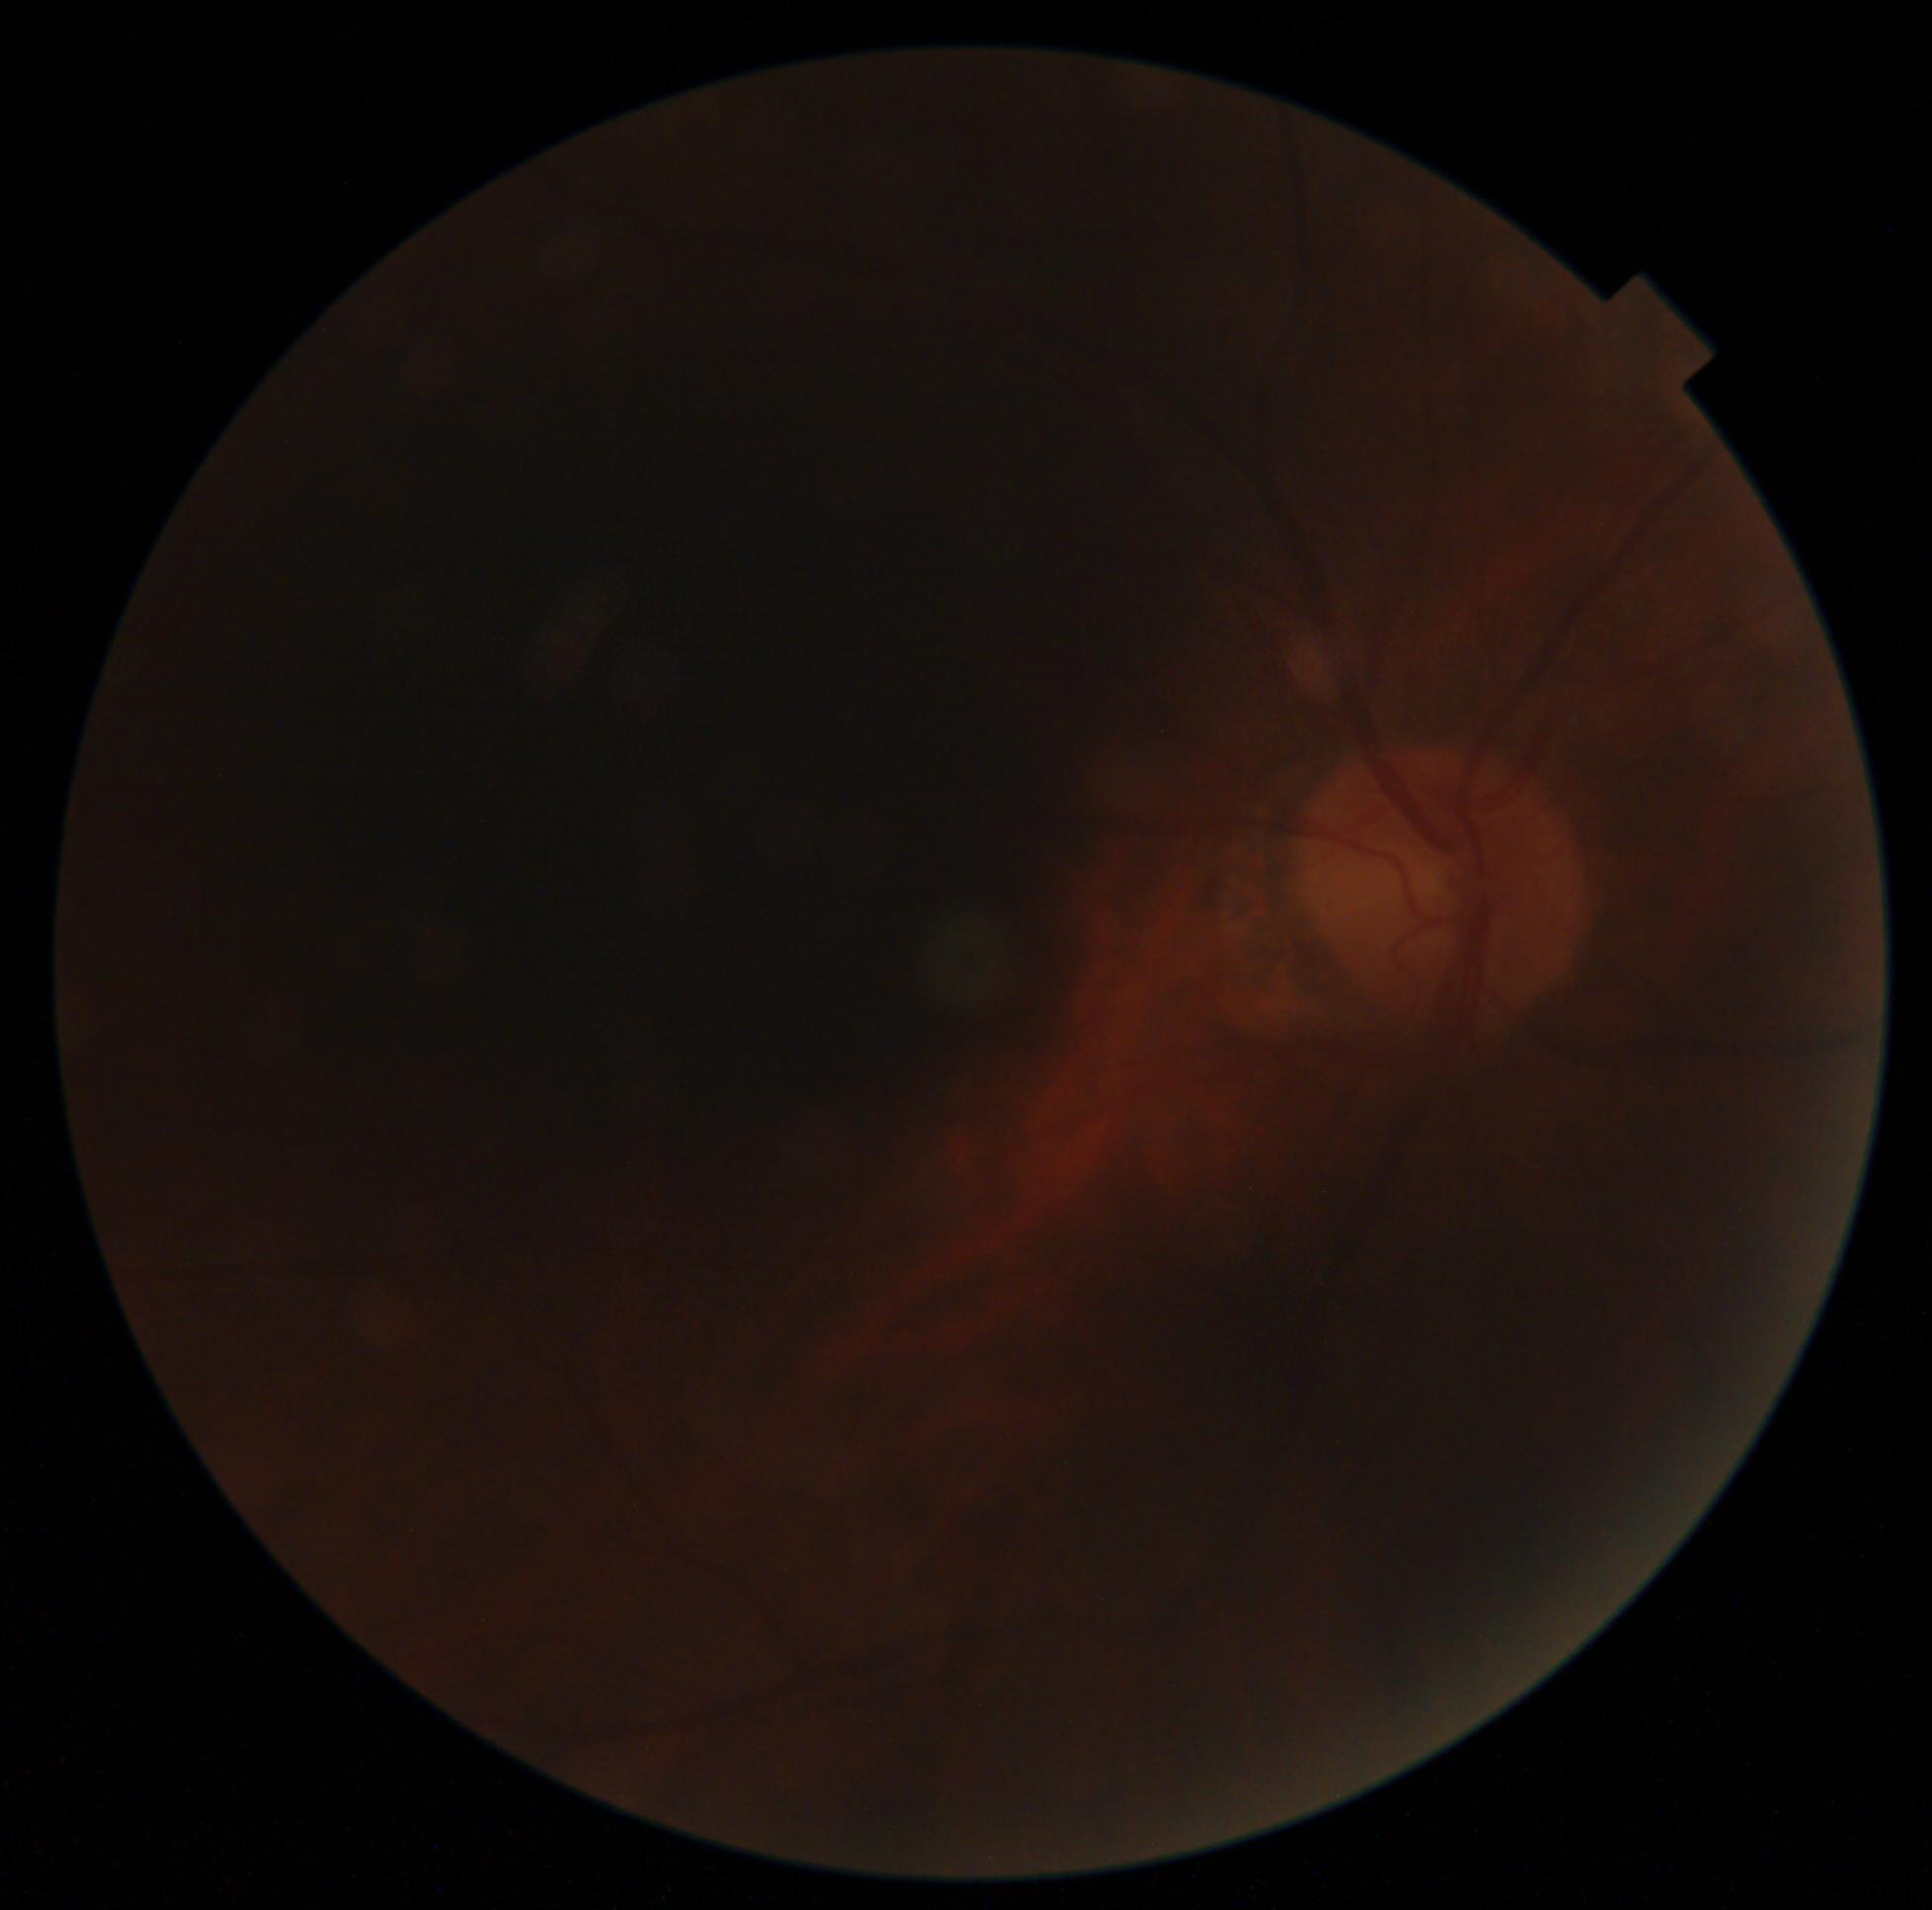
diabetic retinopathy grade = ungradable; image quality = below grading threshold.